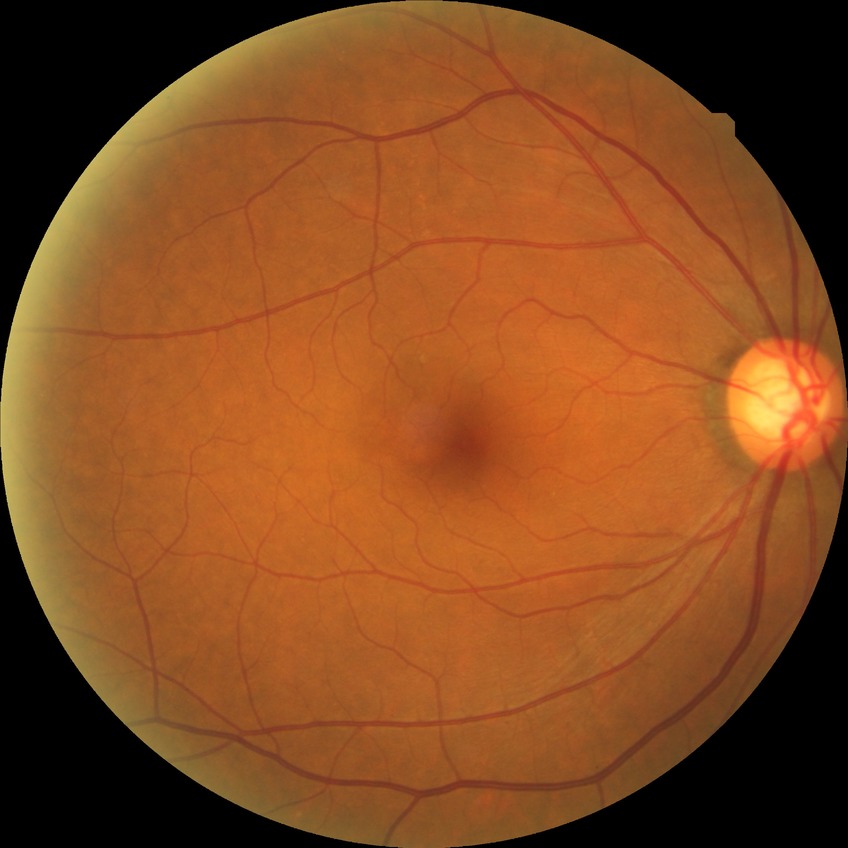
Davis stage: NDR